640 by 480 pixels. Clarity RetCam 3, 130° FOV. Pediatric wide-field fundus photograph:
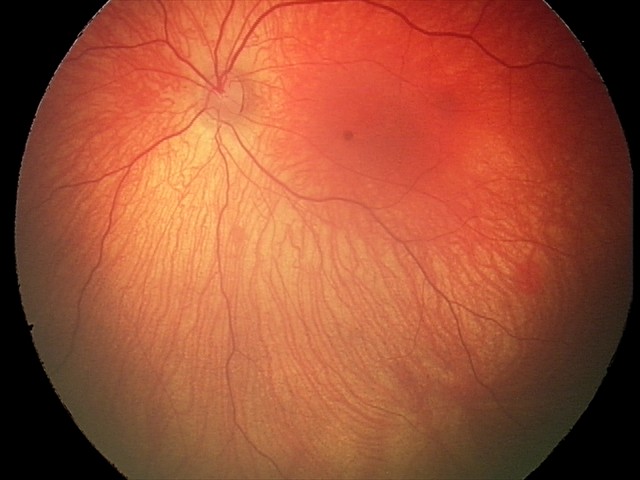
Screening diagnosis = retinal hemorrhages.